Without pupil dilation. NIDEK AFC-230 fundus camera.
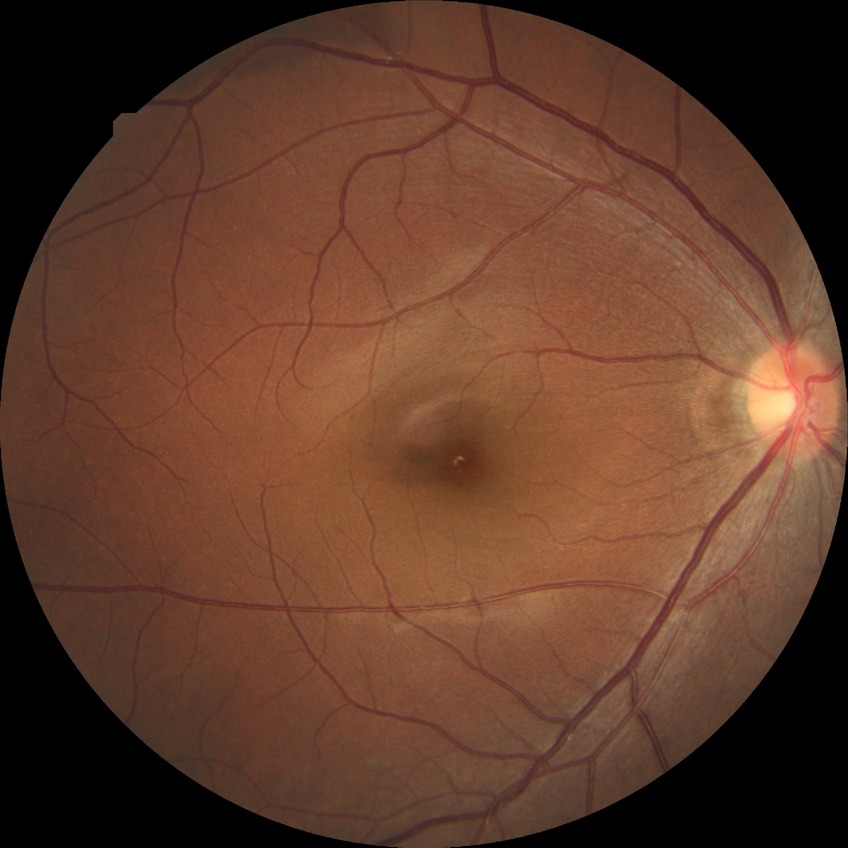

Findings:
* Davis stage: NDR